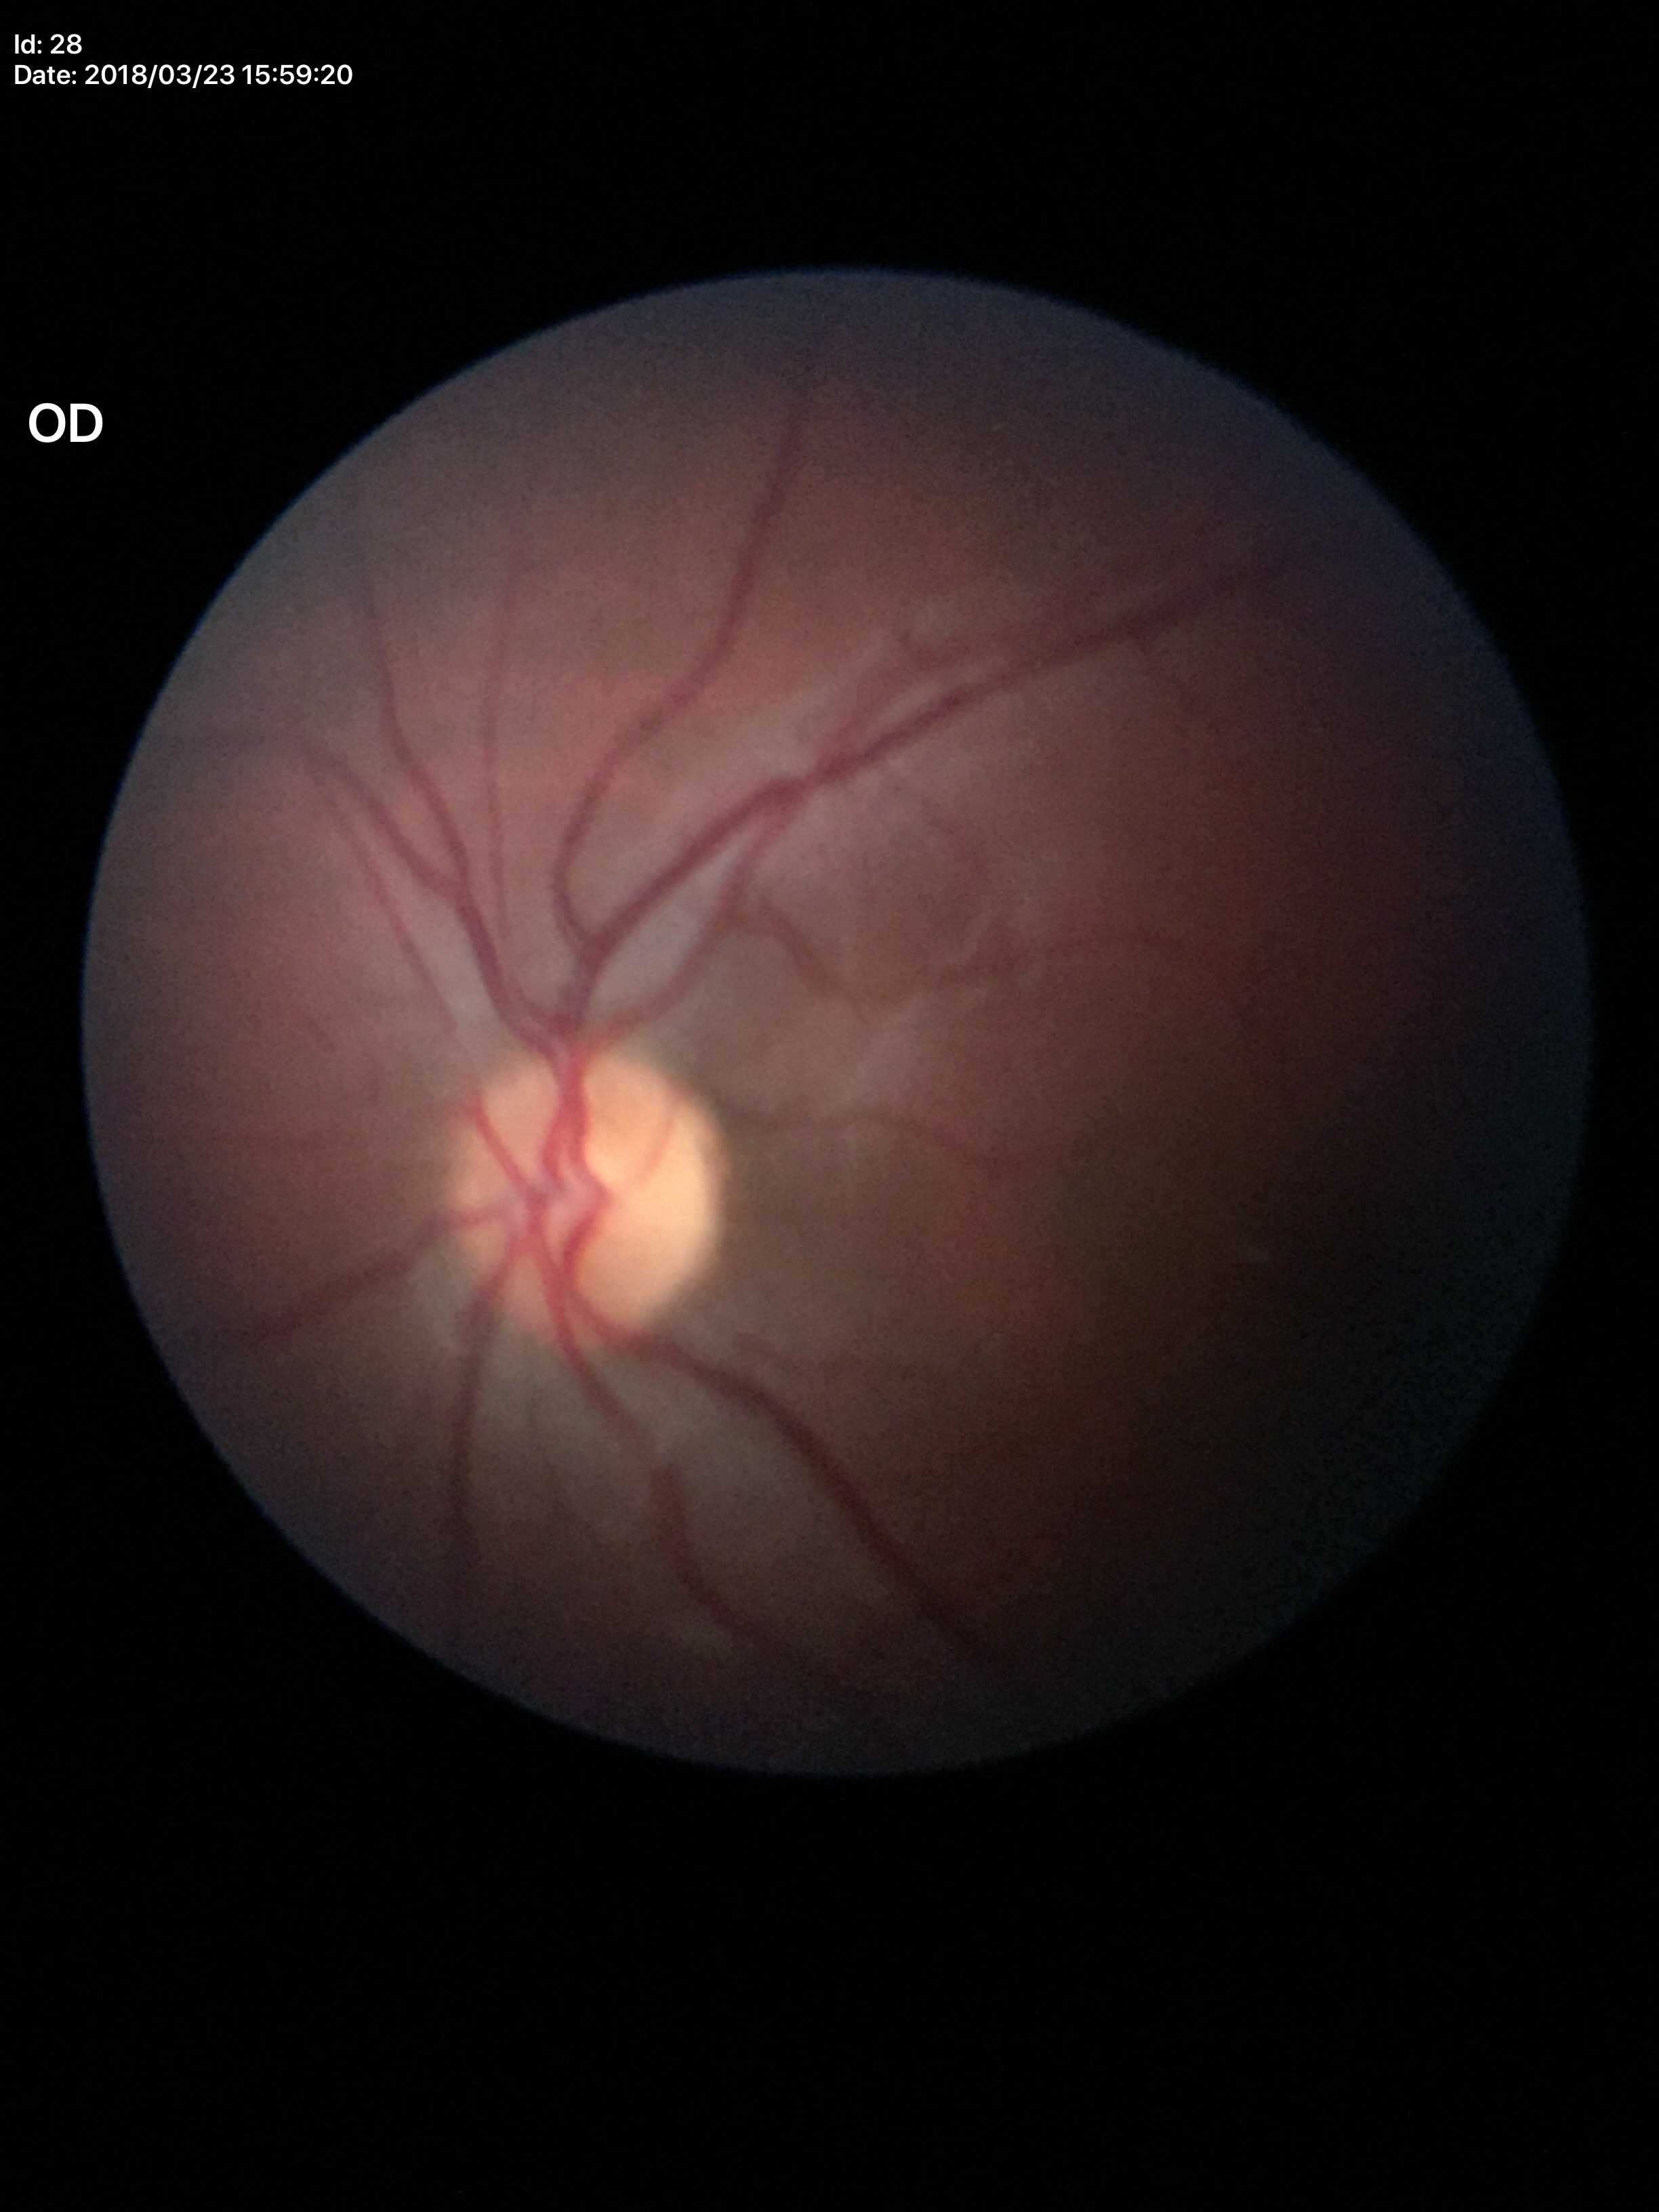

- Glaucoma decision · no suspicious findings
- vertical C/D ratio (VCDR) · 0.45